2048x1536: 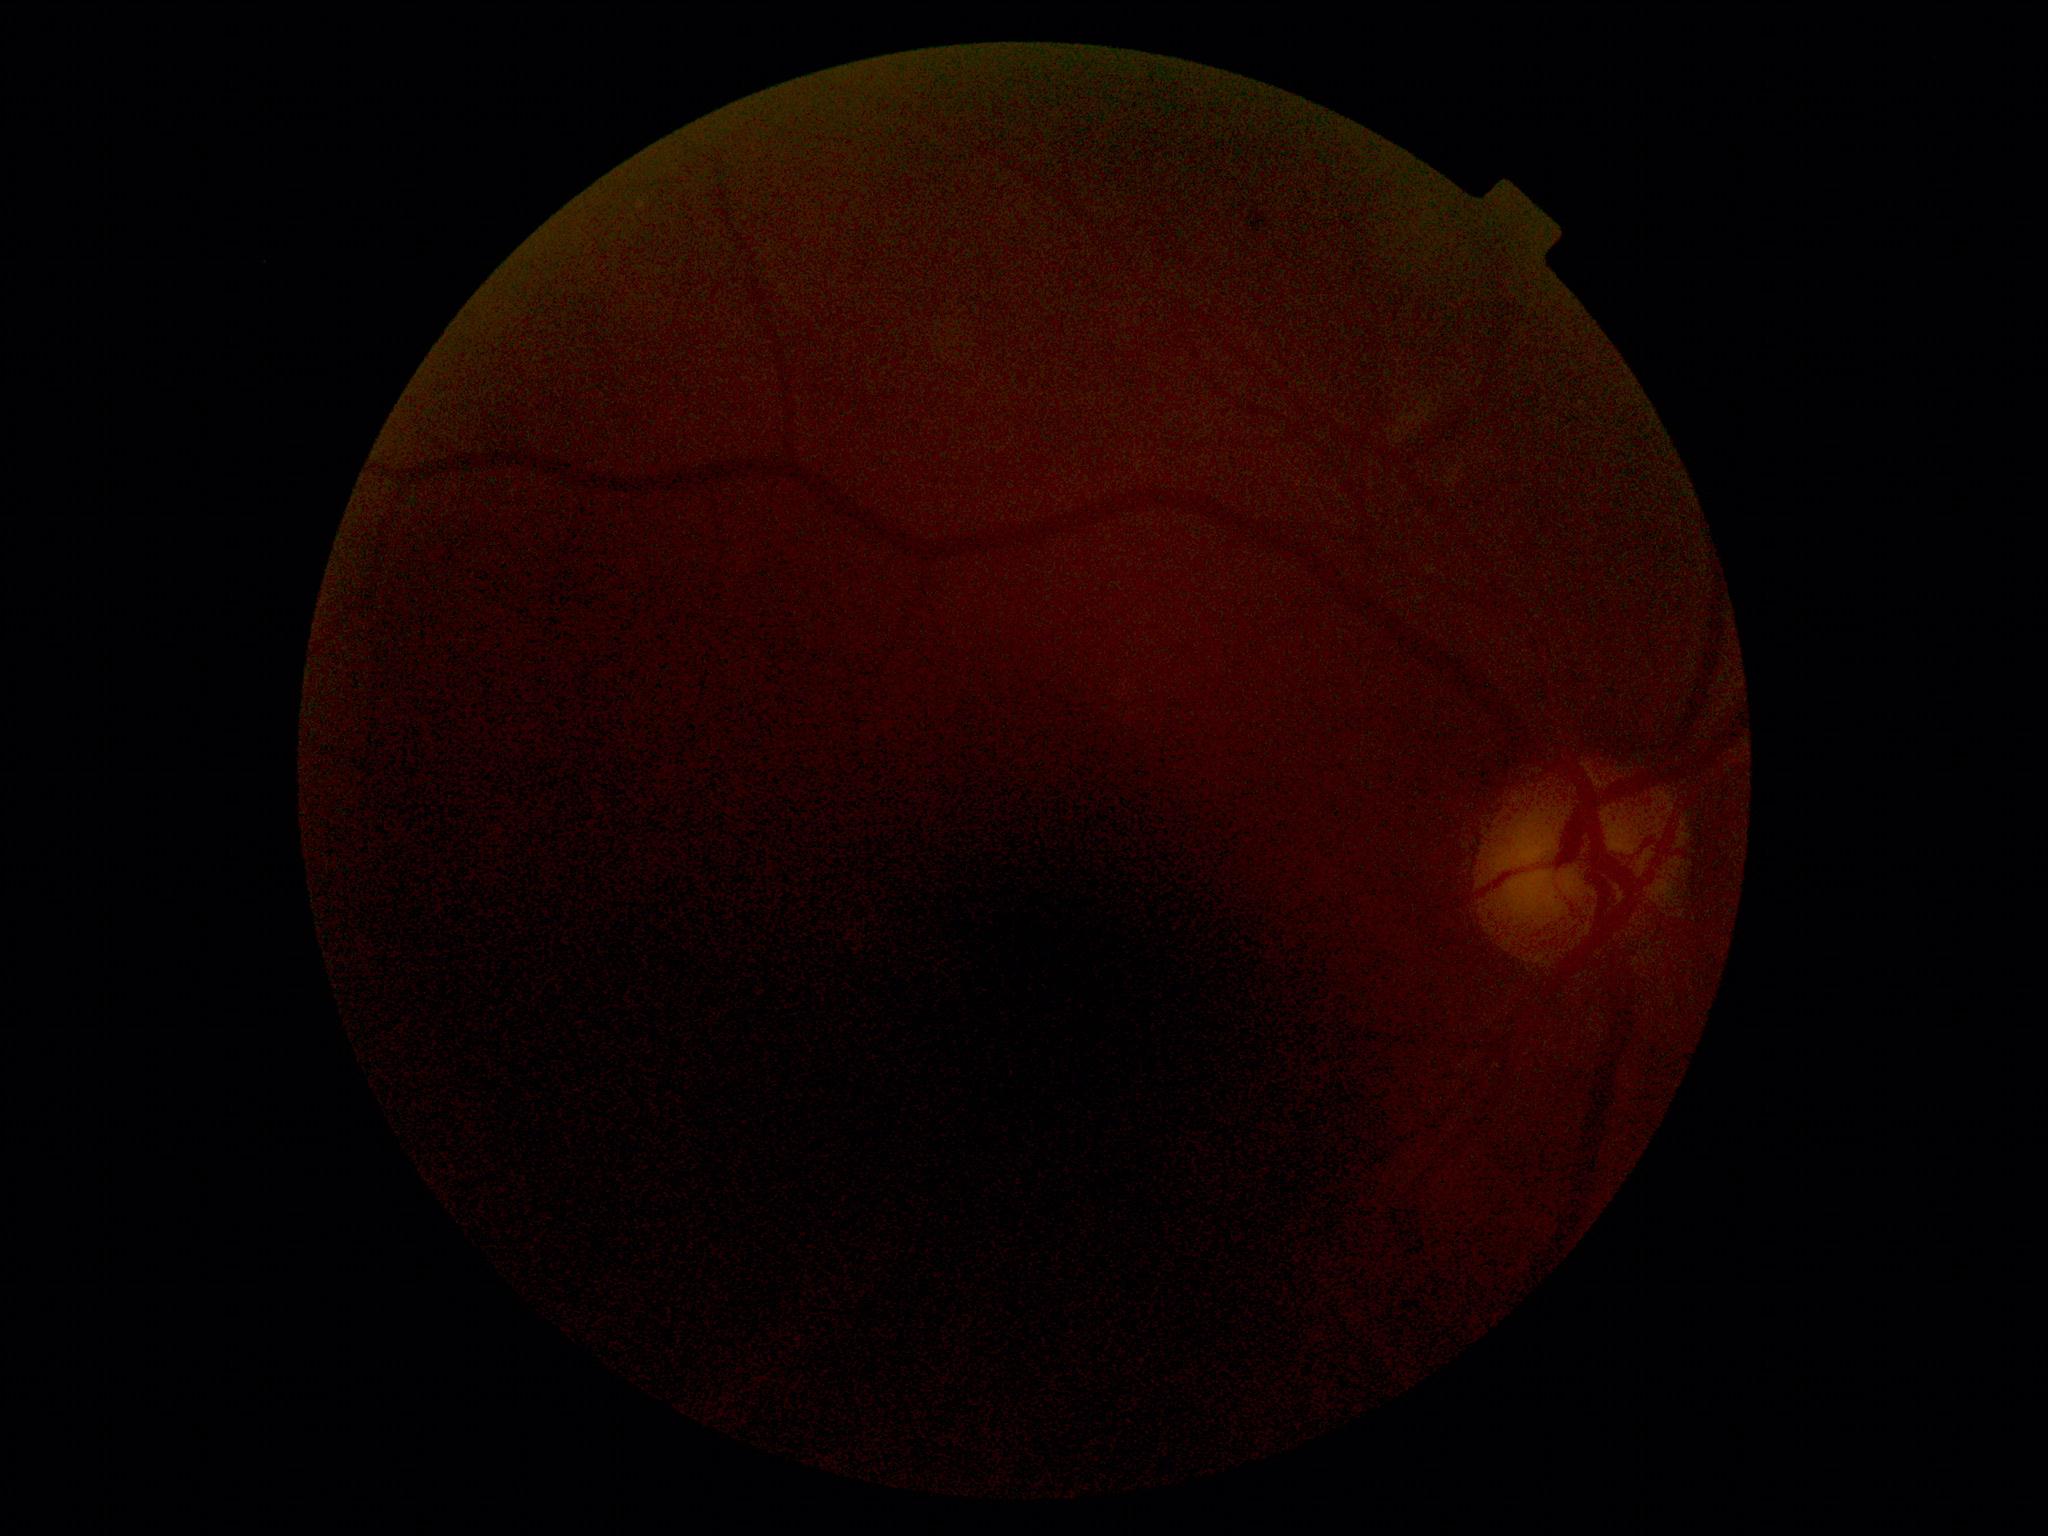 DR severity: ungradable.